Captured with the Clarity RetCam 3 (130° field of view) · wide-field fundus image from infant ROP screening: 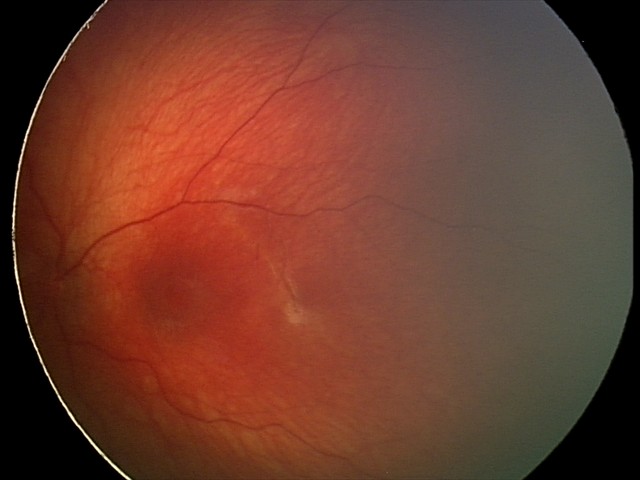 From an examination with diagnosis of optic nerve hypoplasia.